1504 x 1000 pixels — 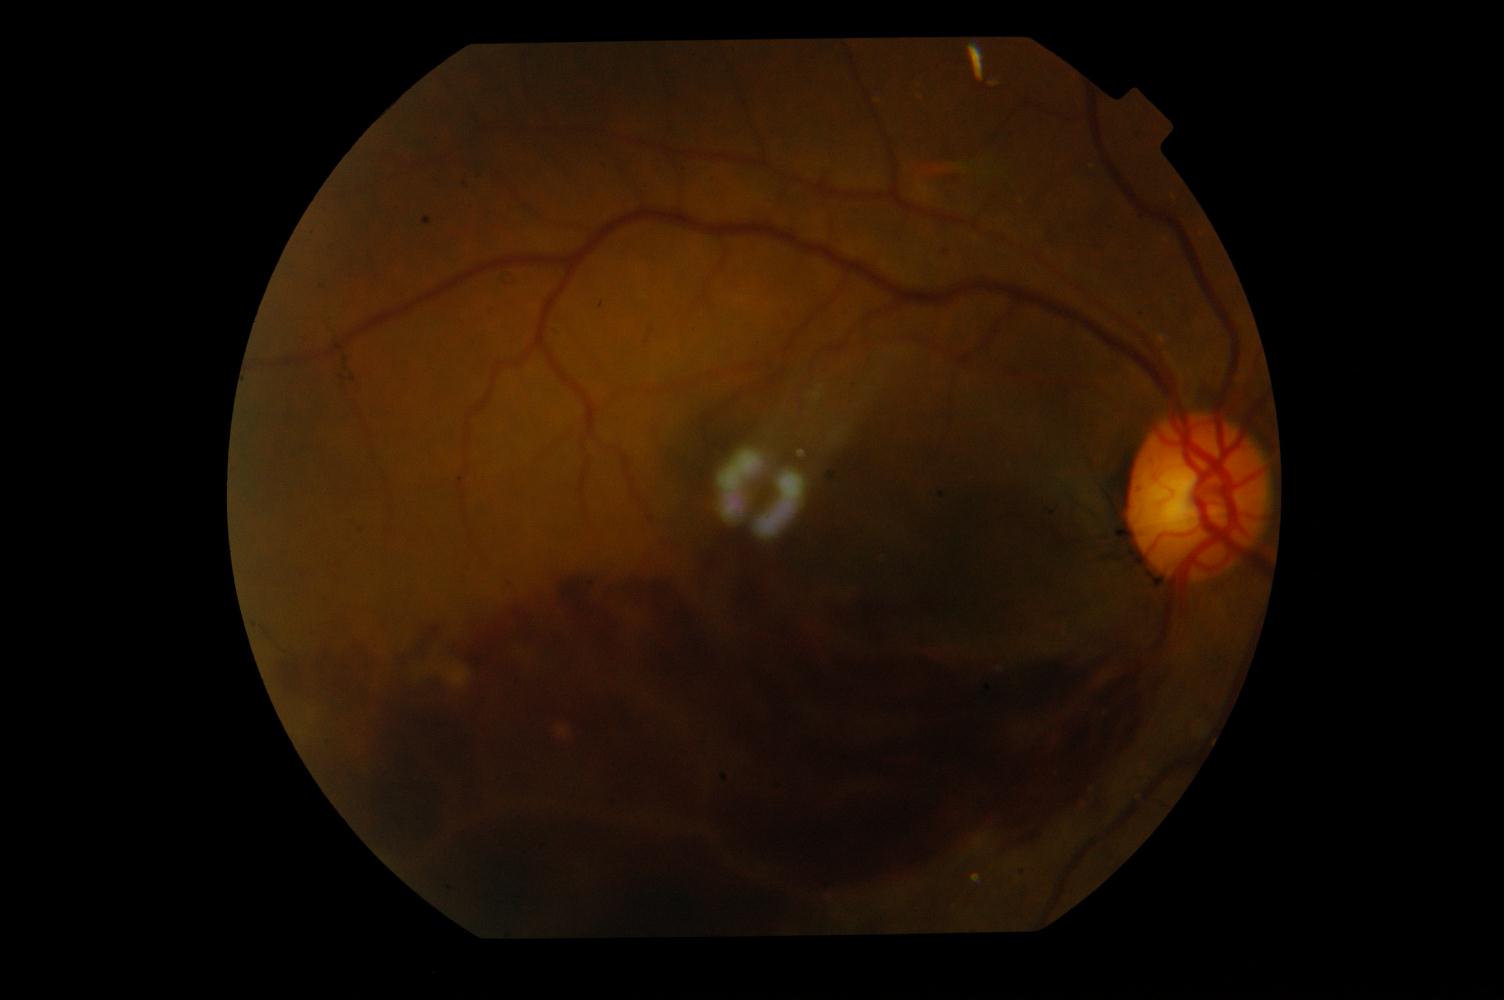
Abnormalities:
- branch retinal vein occlusion (BRVO)